2352 by 1568 pixels: 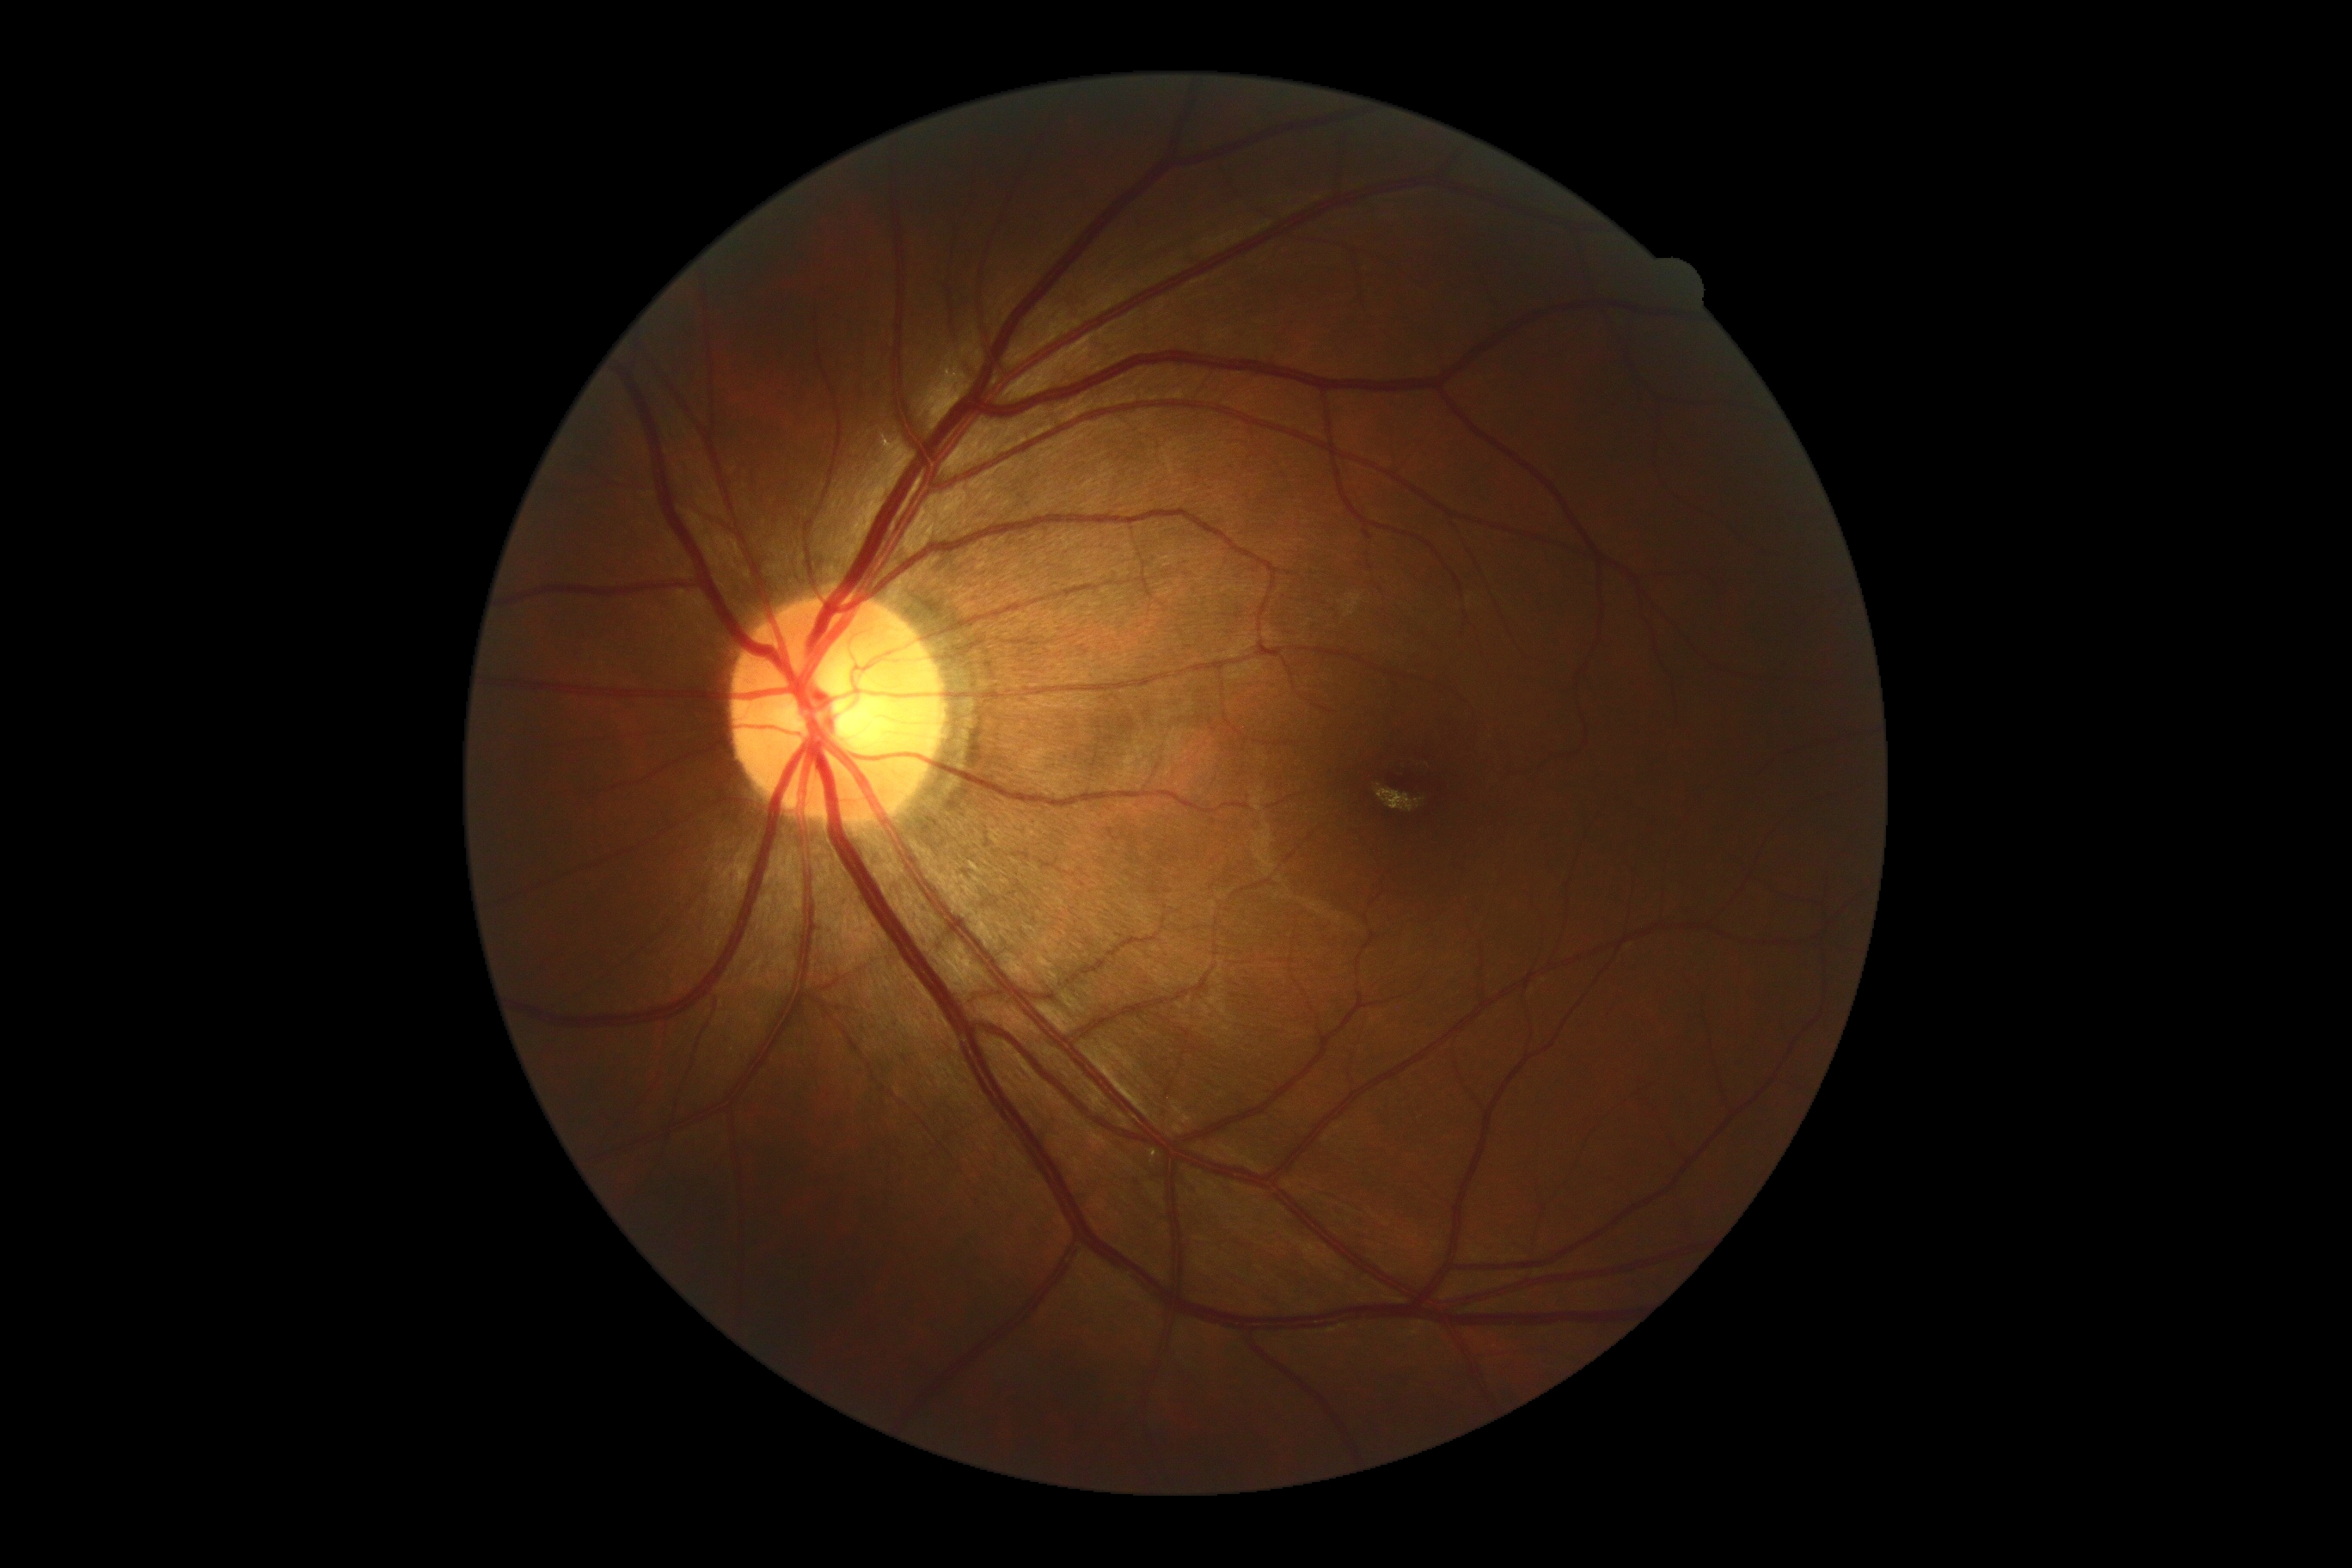
DR grade@no apparent retinopathy (0).